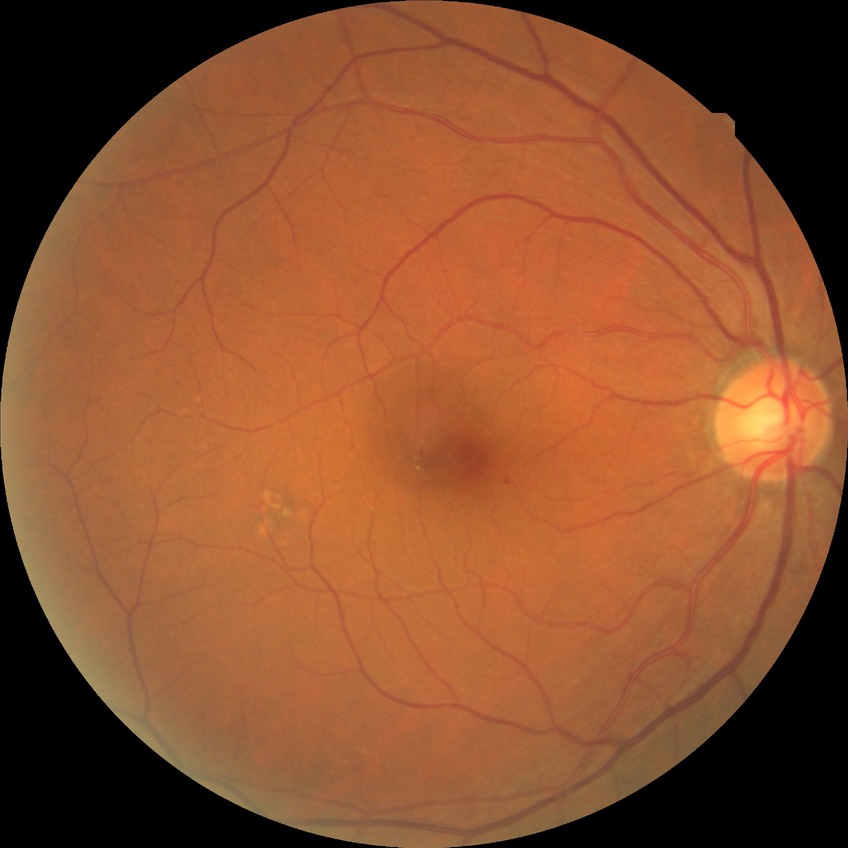

DR severity is SDR.